Image size 1932x1916; FOV: 45 degrees: 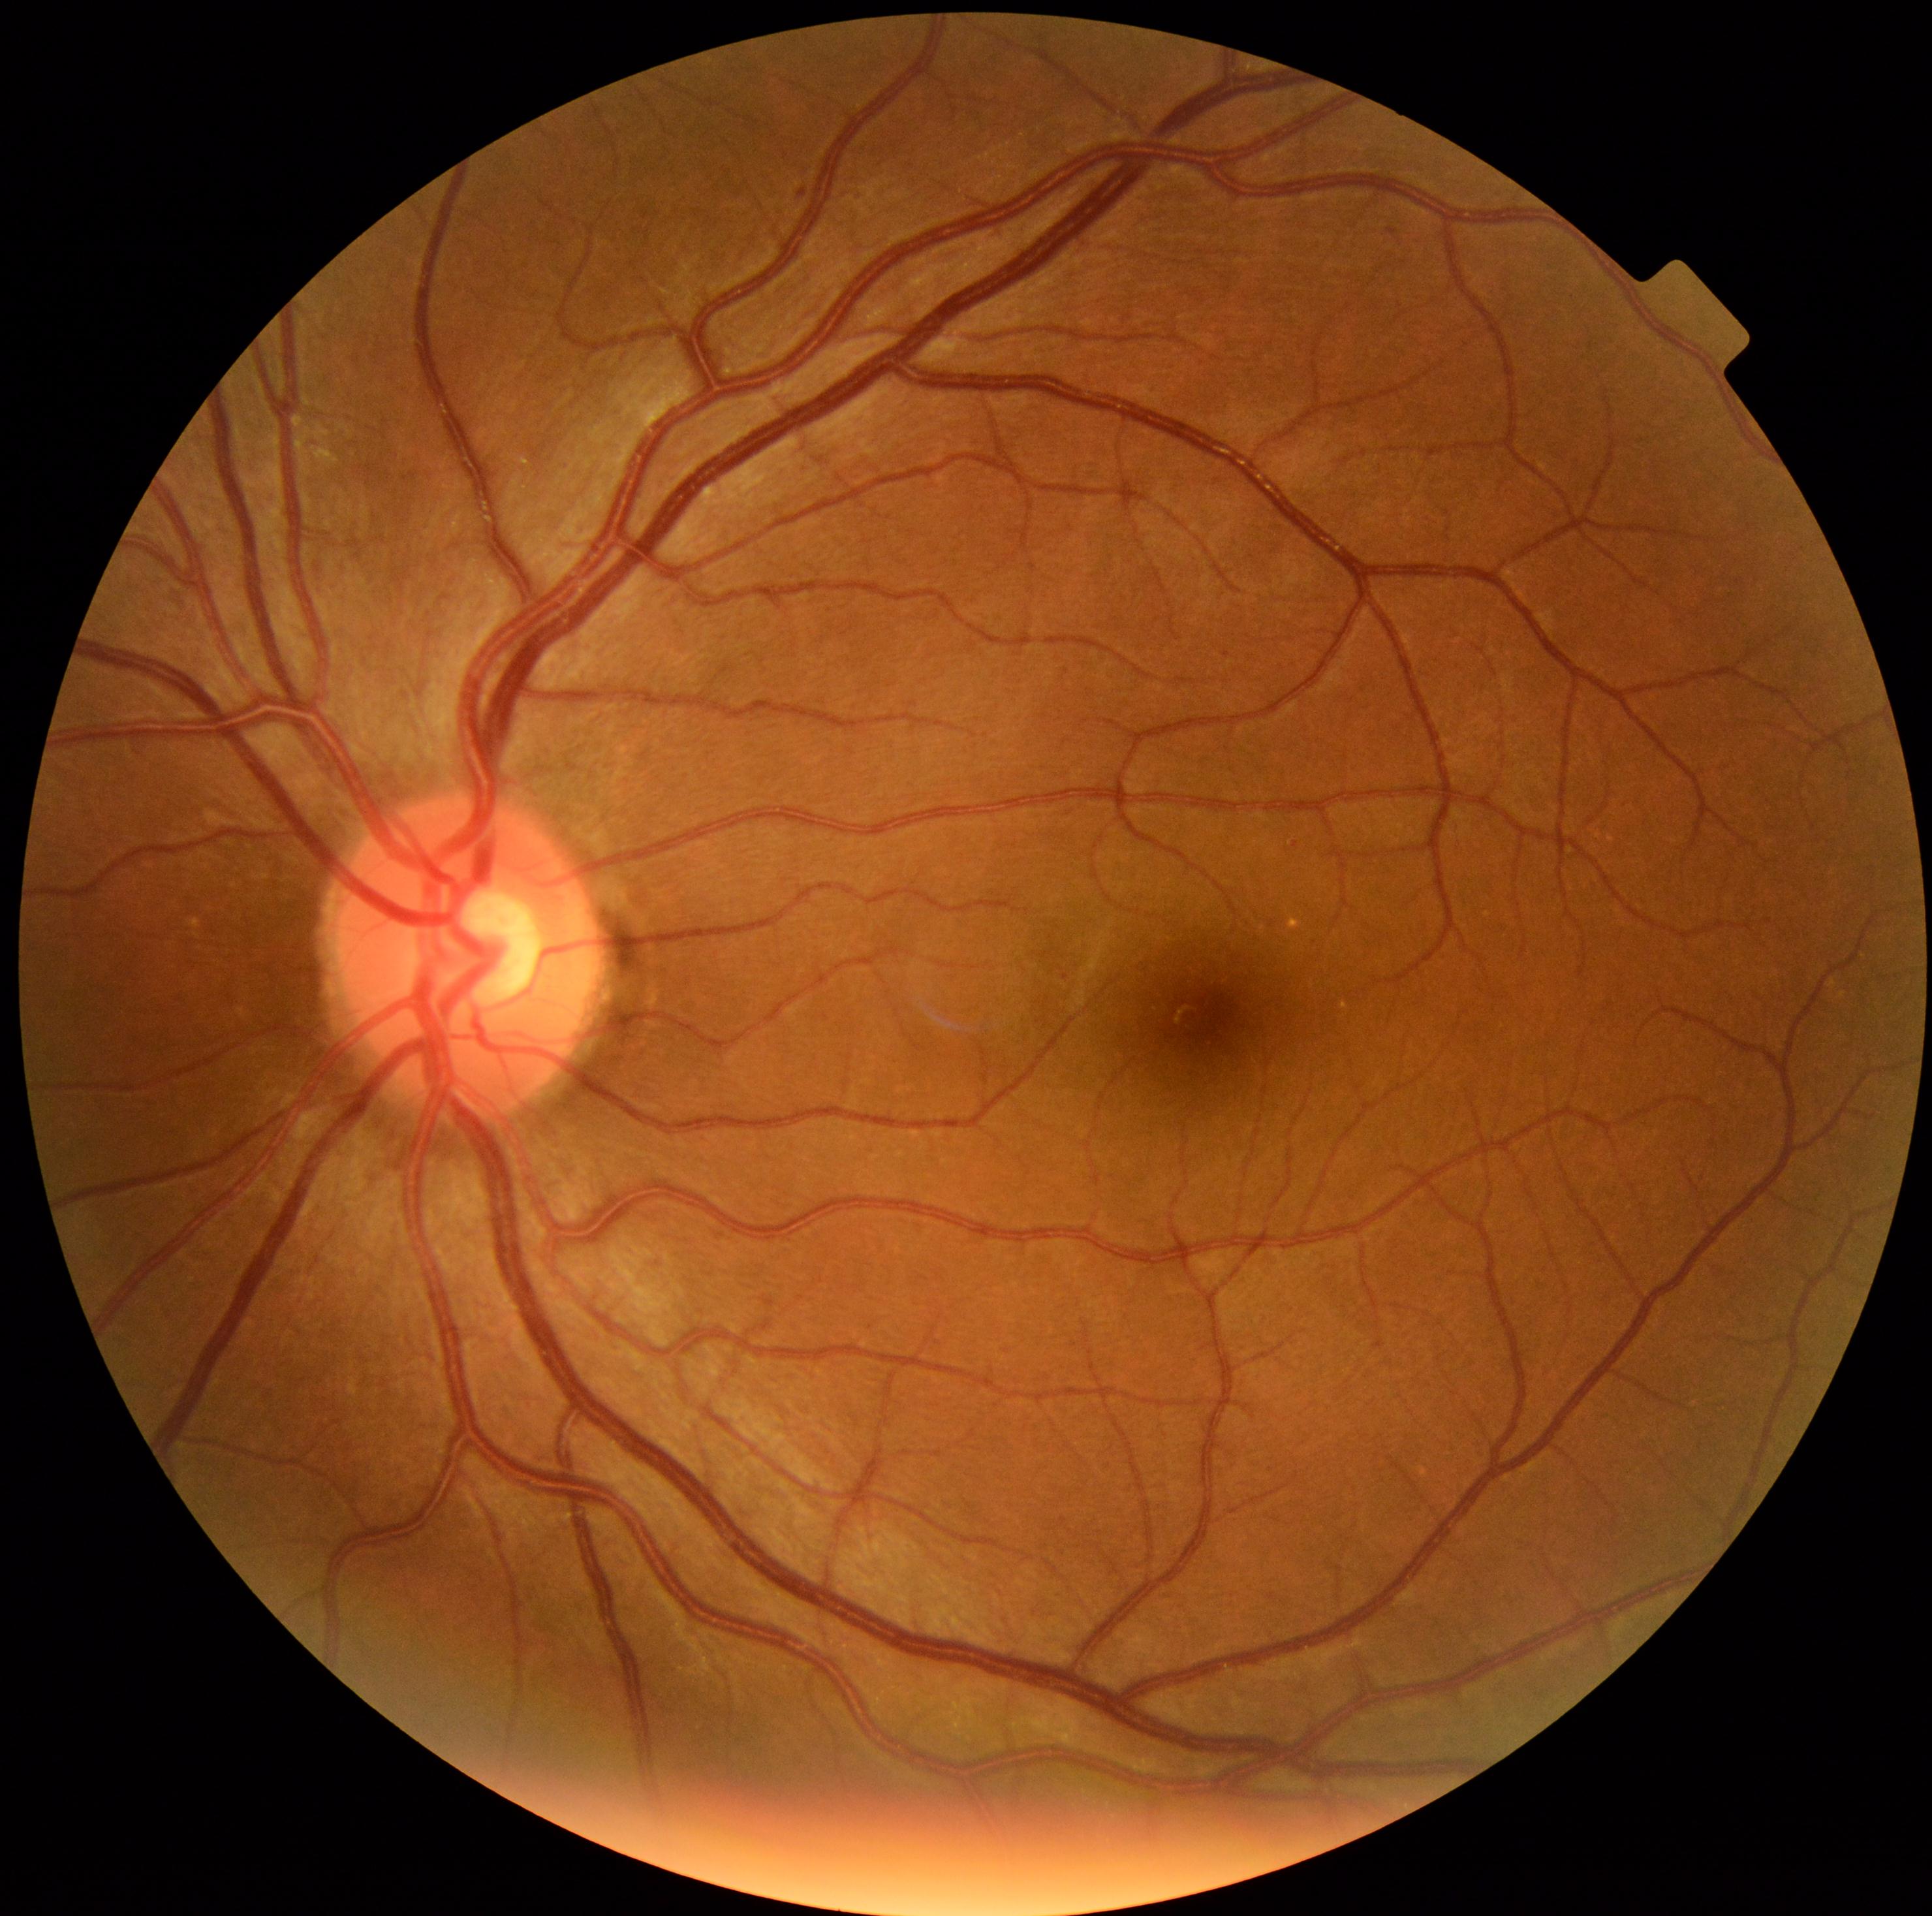 {"dr_grade": "1/4", "dr_category": "non-proliferative diabetic retinopathy"}